848x848px — 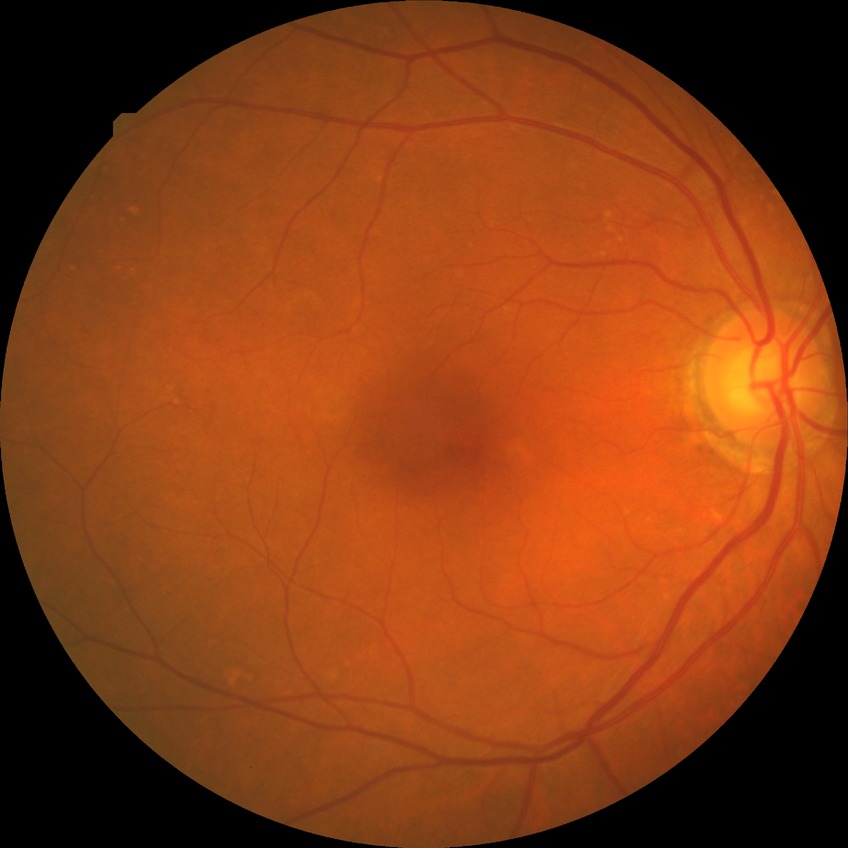

dr_impression: no apparent DR
davis_grade: NDR